45 degree fundus photograph, 848 by 848 pixels.
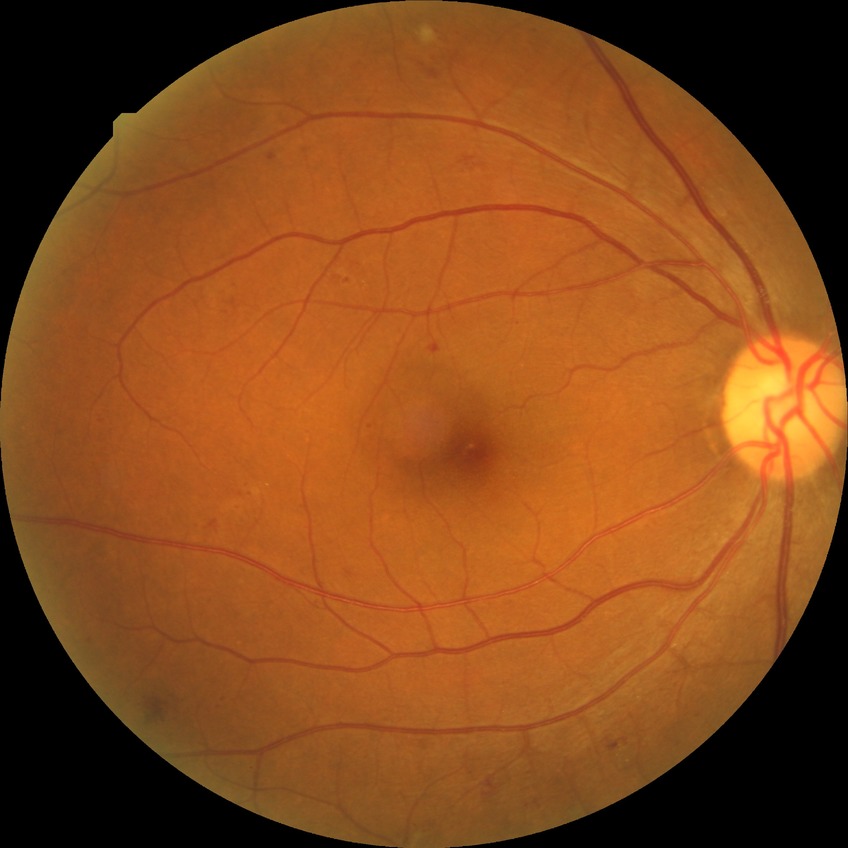 {"proliferative_class": "non-proliferative diabetic retinopathy", "davis_grade": "simple diabetic retinopathy"}